FOV: 45 degrees.
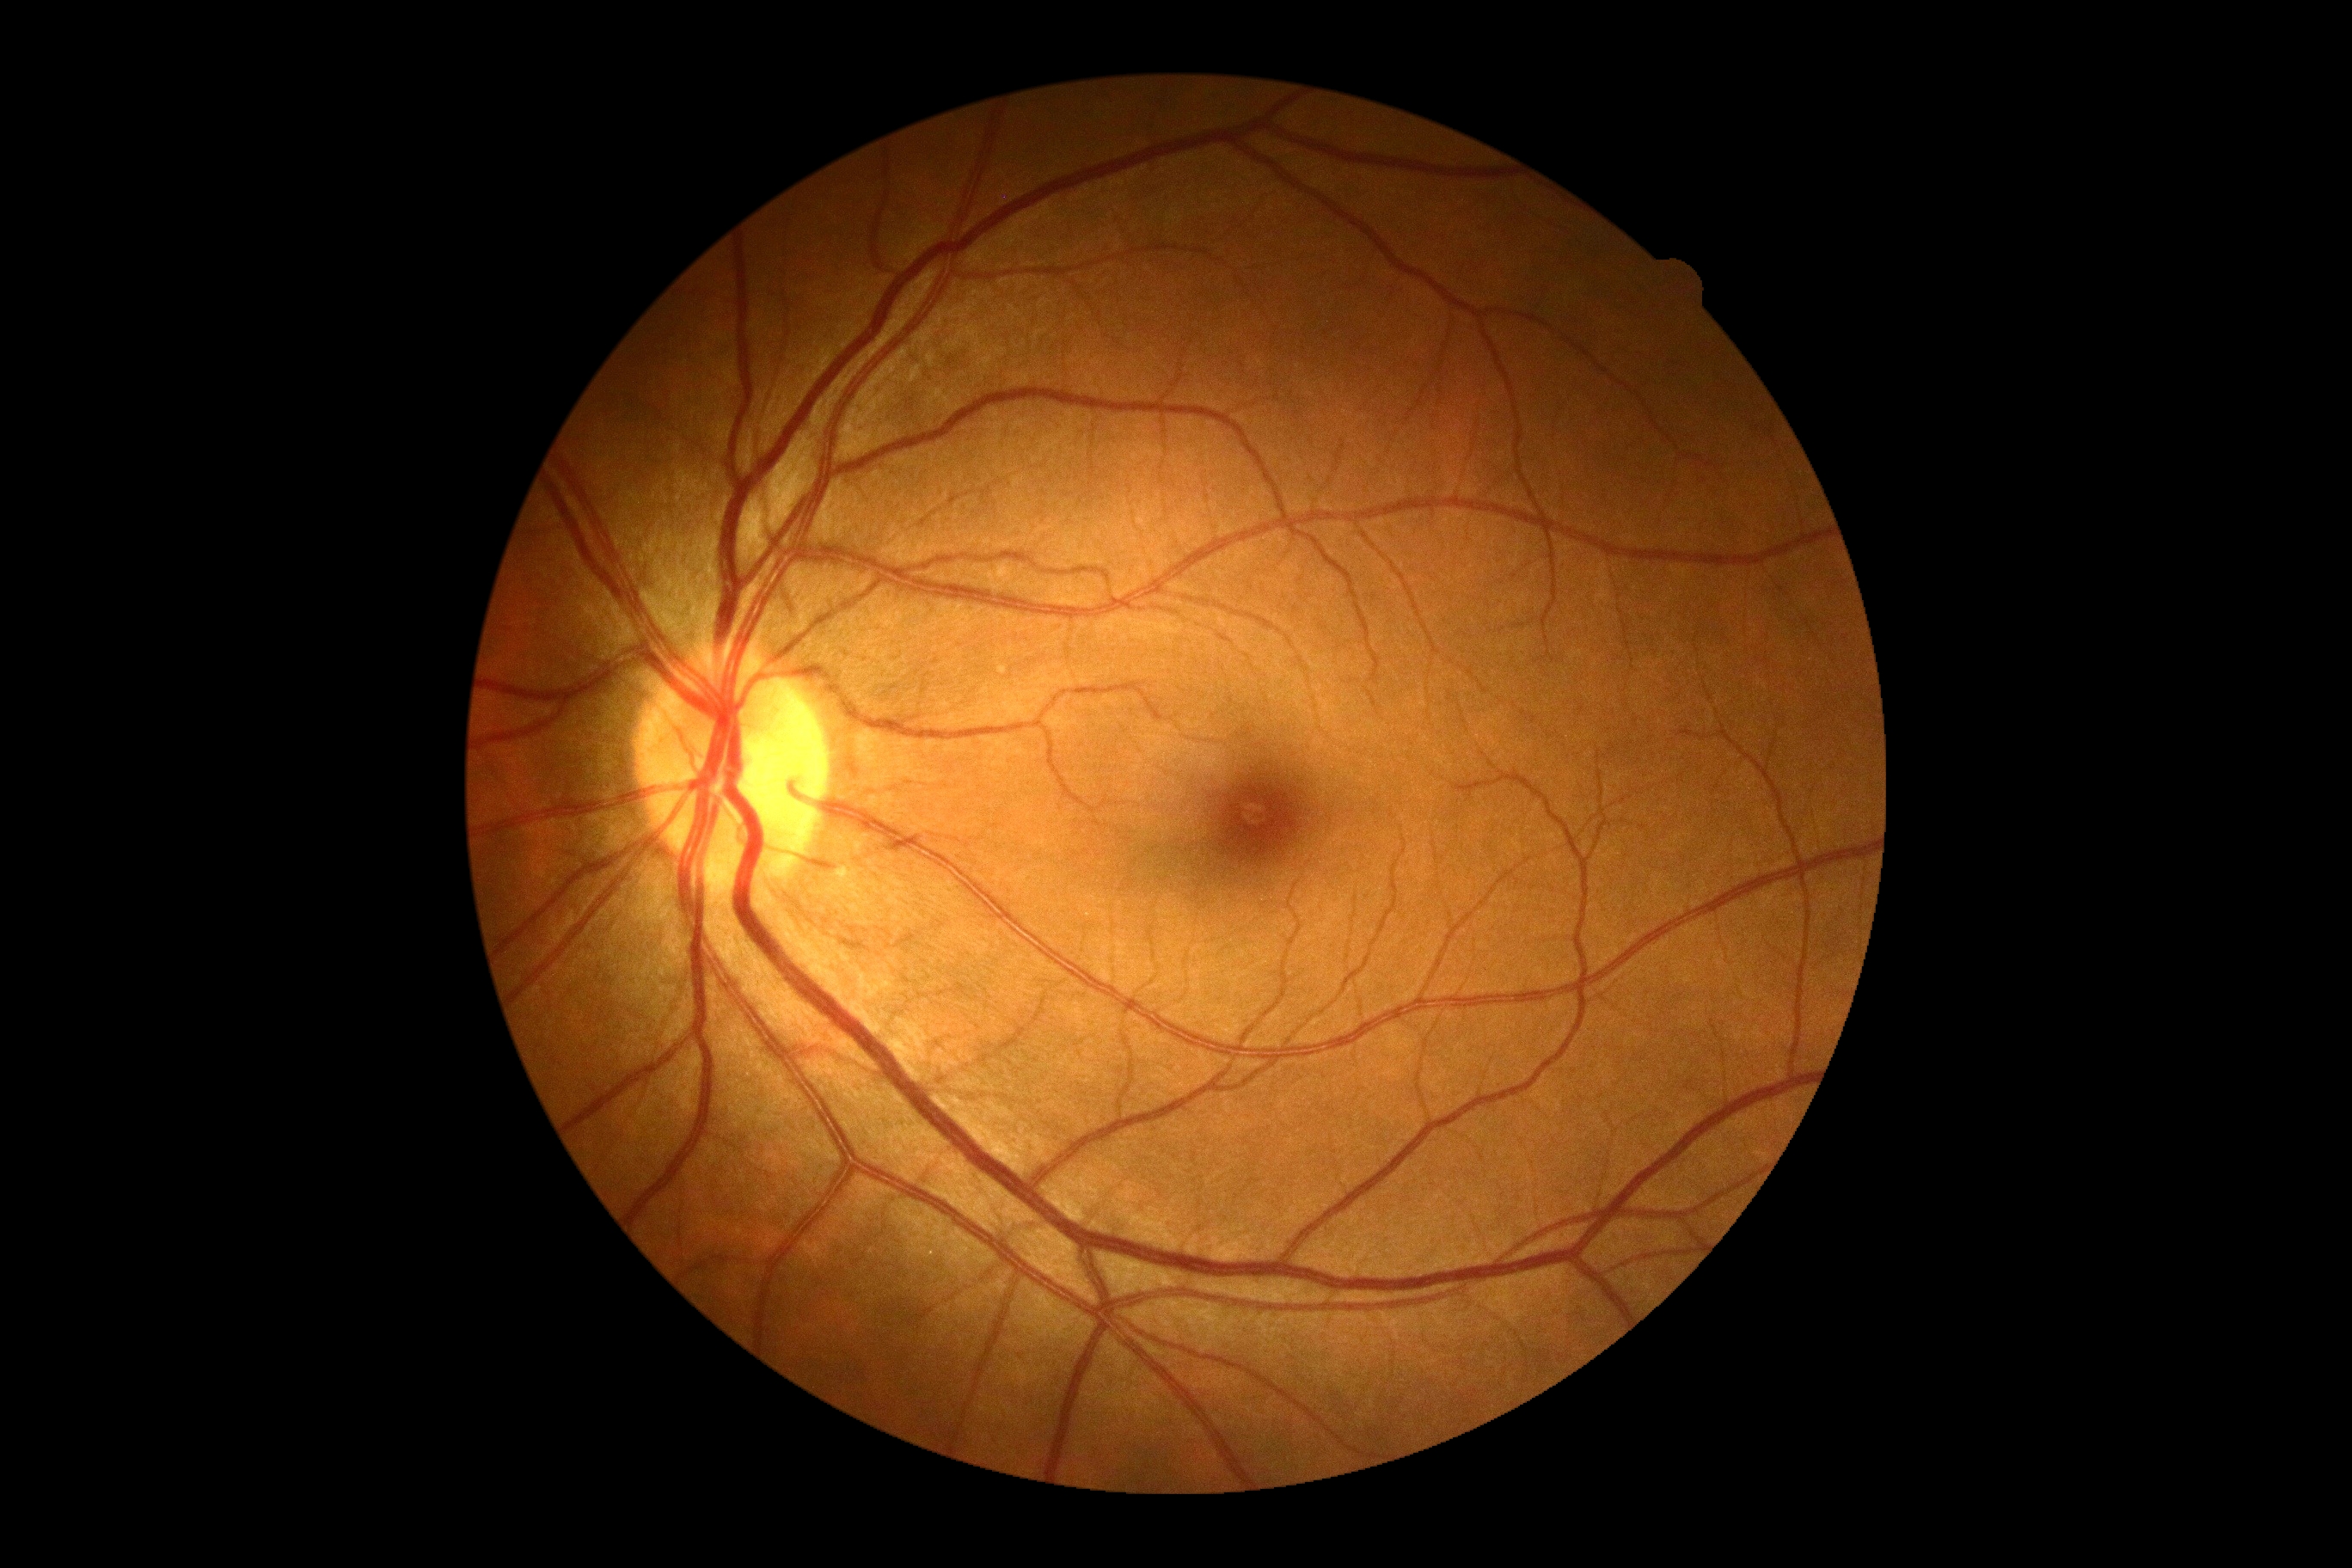
Annotations:
– DR grade — no apparent diabetic retinopathy (0)